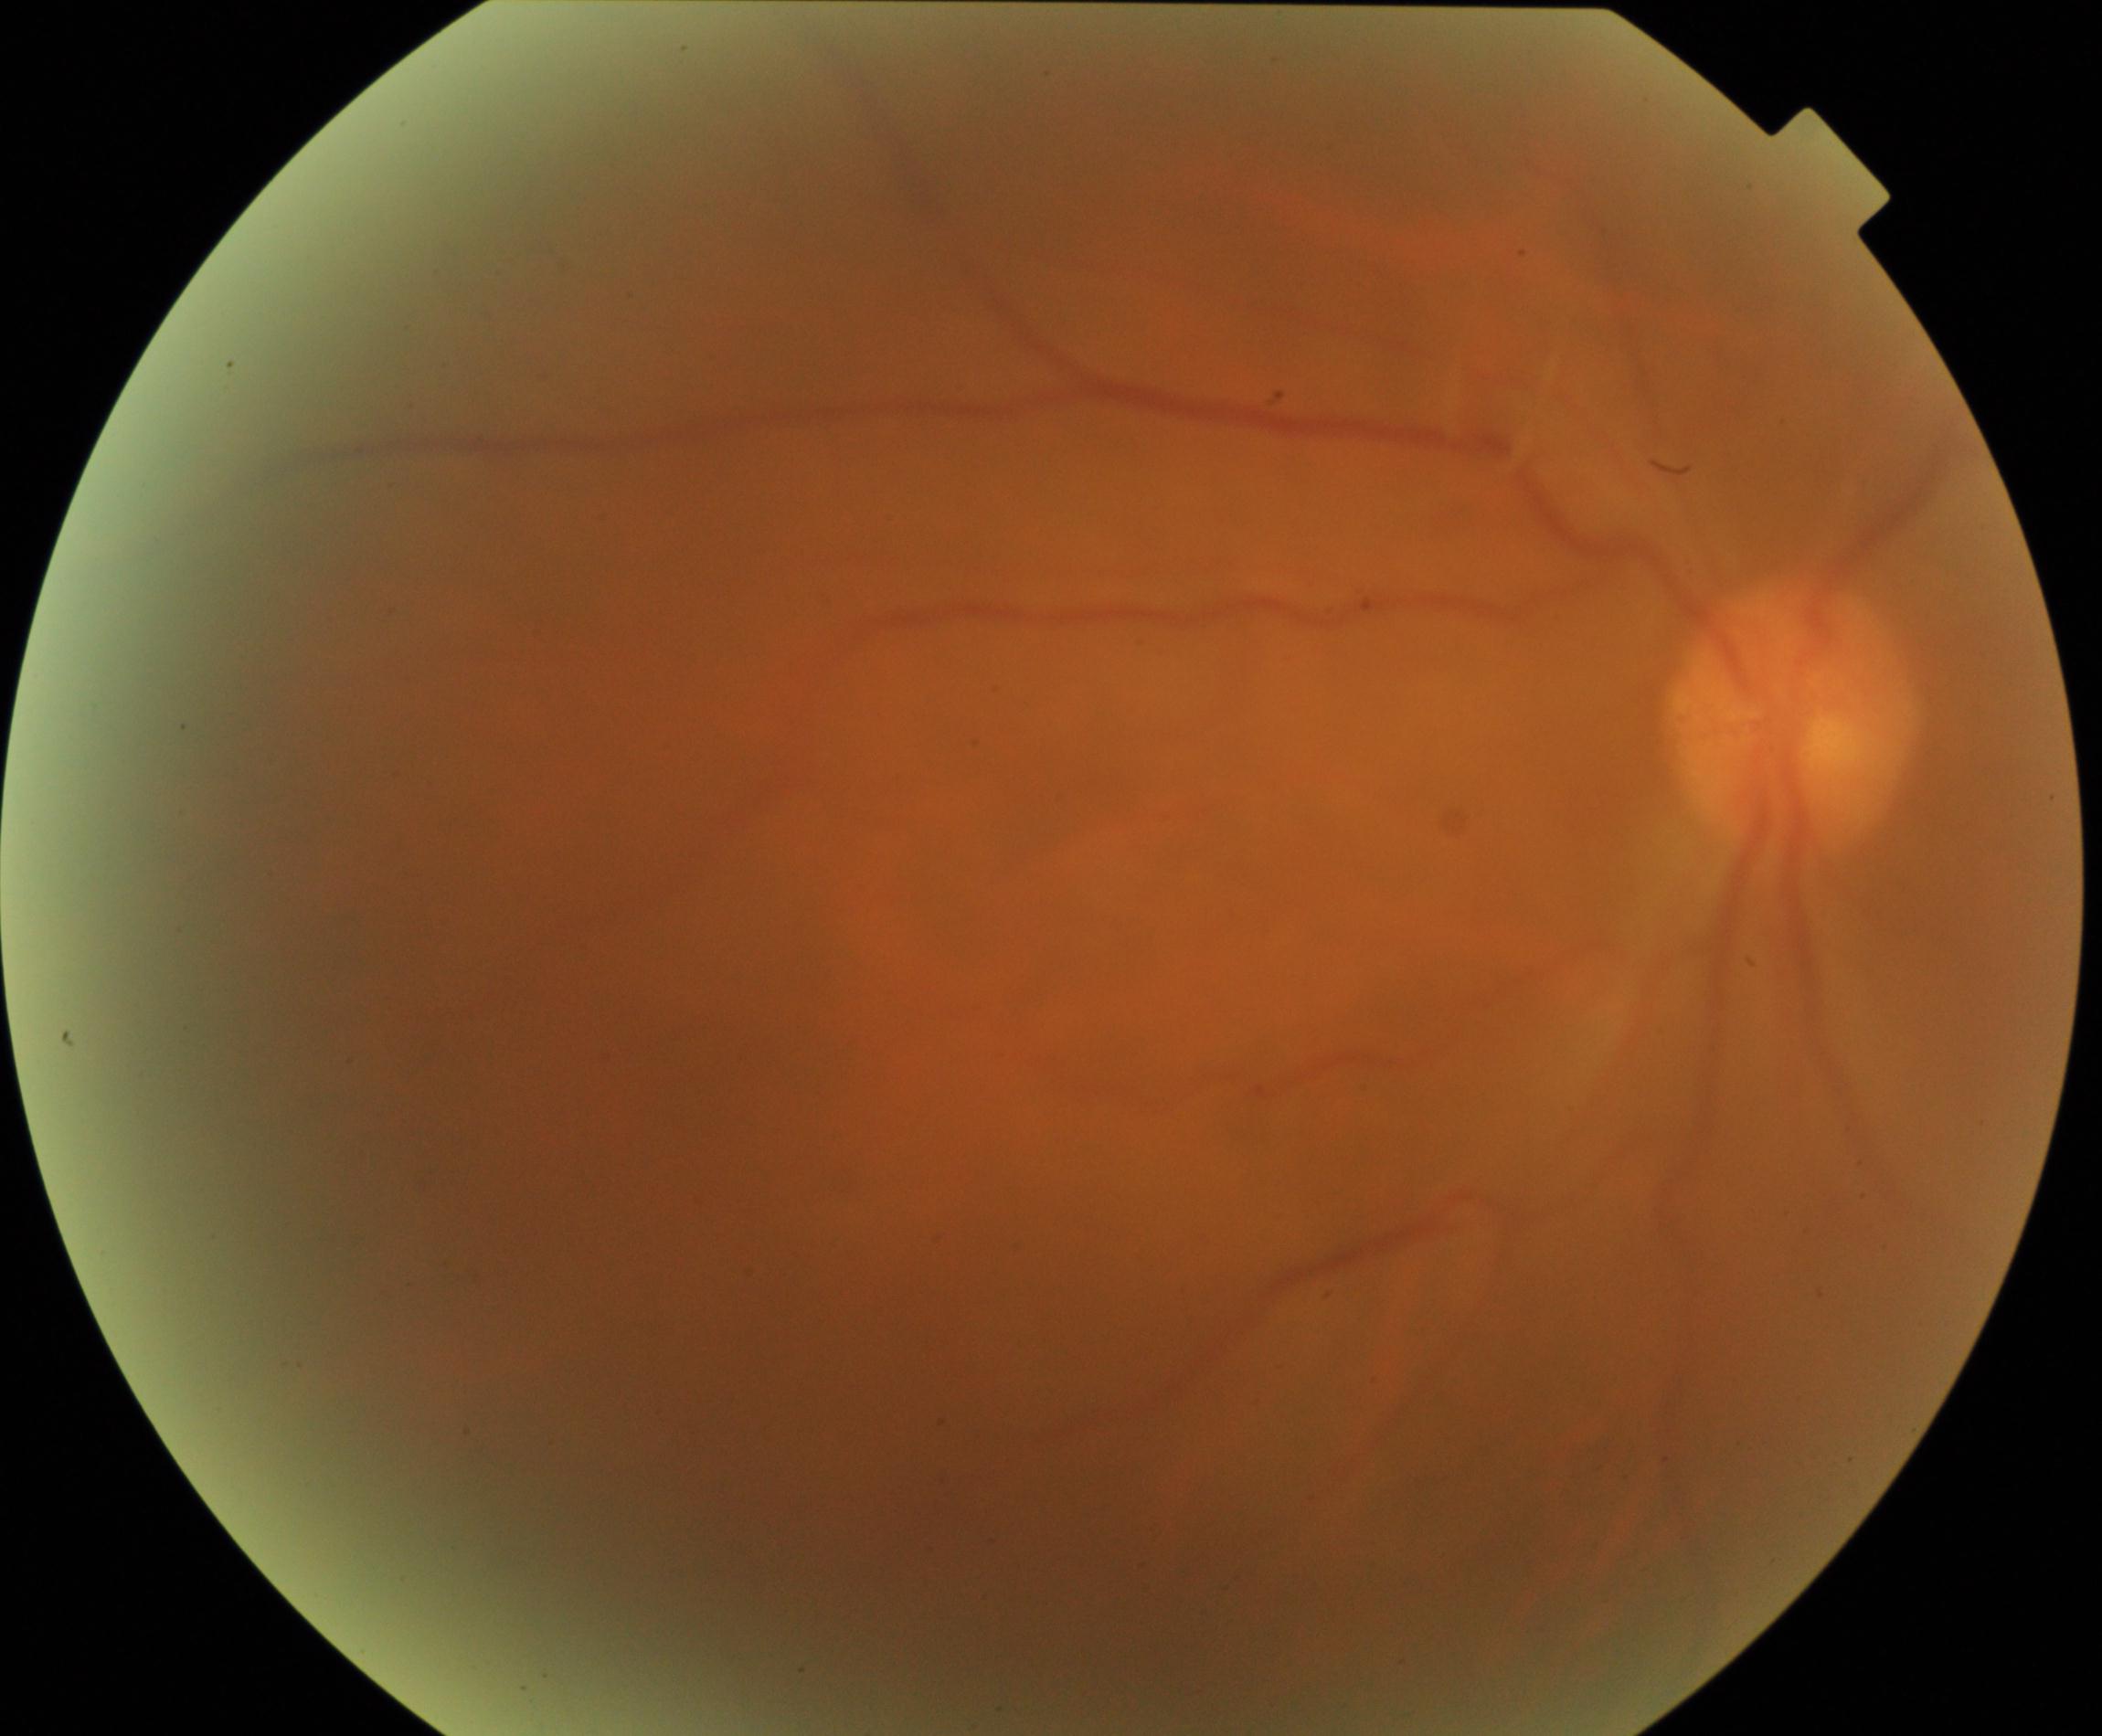

Poor-quality fundus photograph; retinal landmarks are largely obscured. No evidence of proliferative diabetic retinopathy.